1920x1440px, color fundus image, captured on a Bosch handheld fundus camera
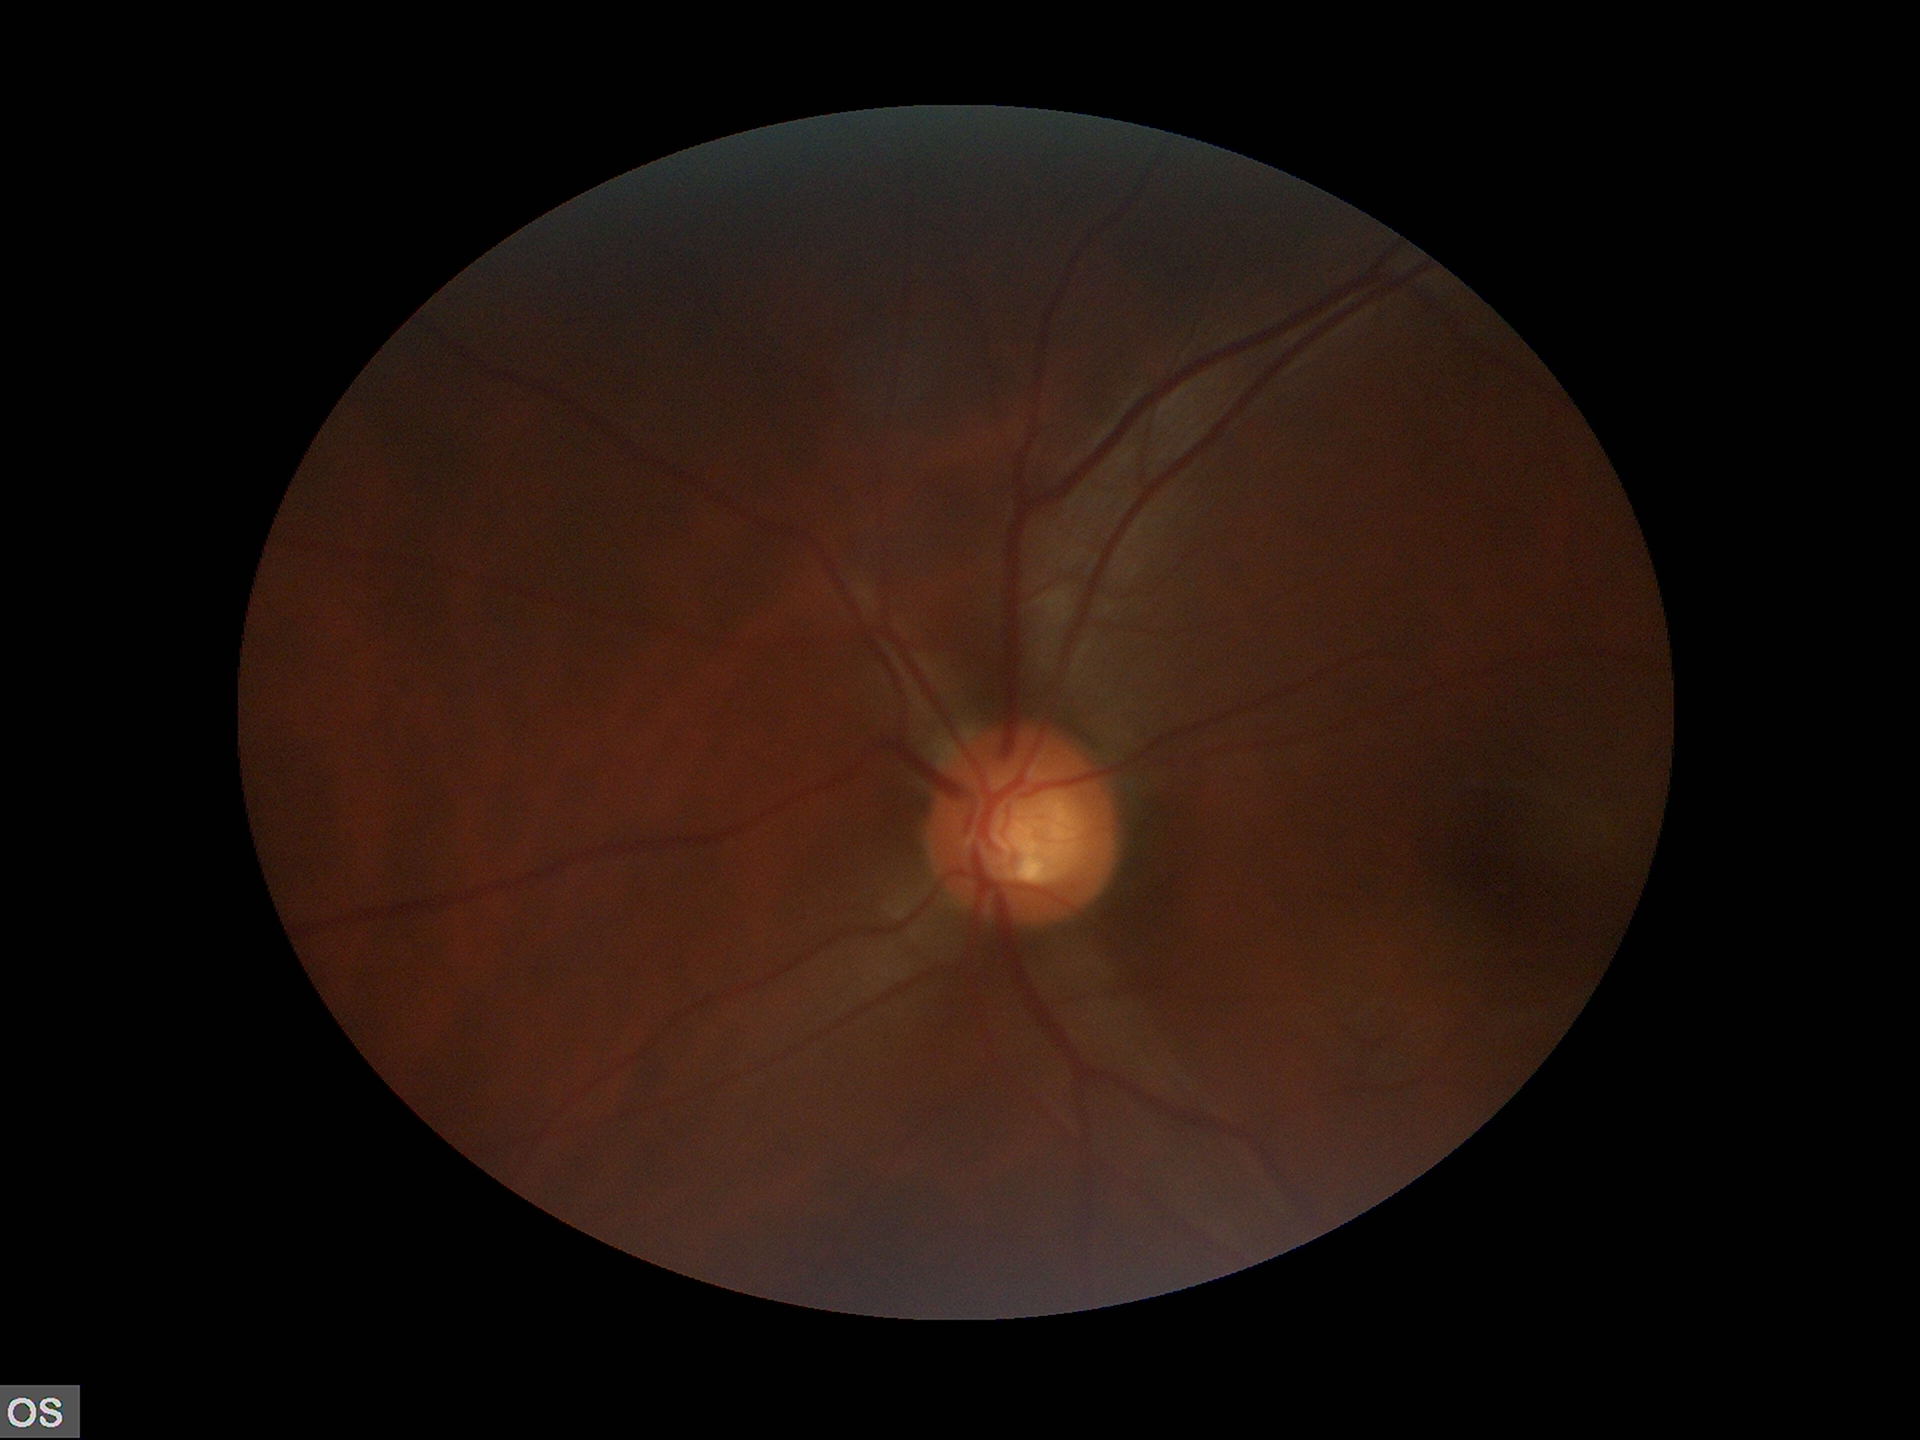 Horizontal cup-to-disc ratio (HCDR) is 0.57. Glaucoma decision: negative (two of five ophthalmologists flagged glaucoma suspect). Vertical CDR (VCDR): 0.57.